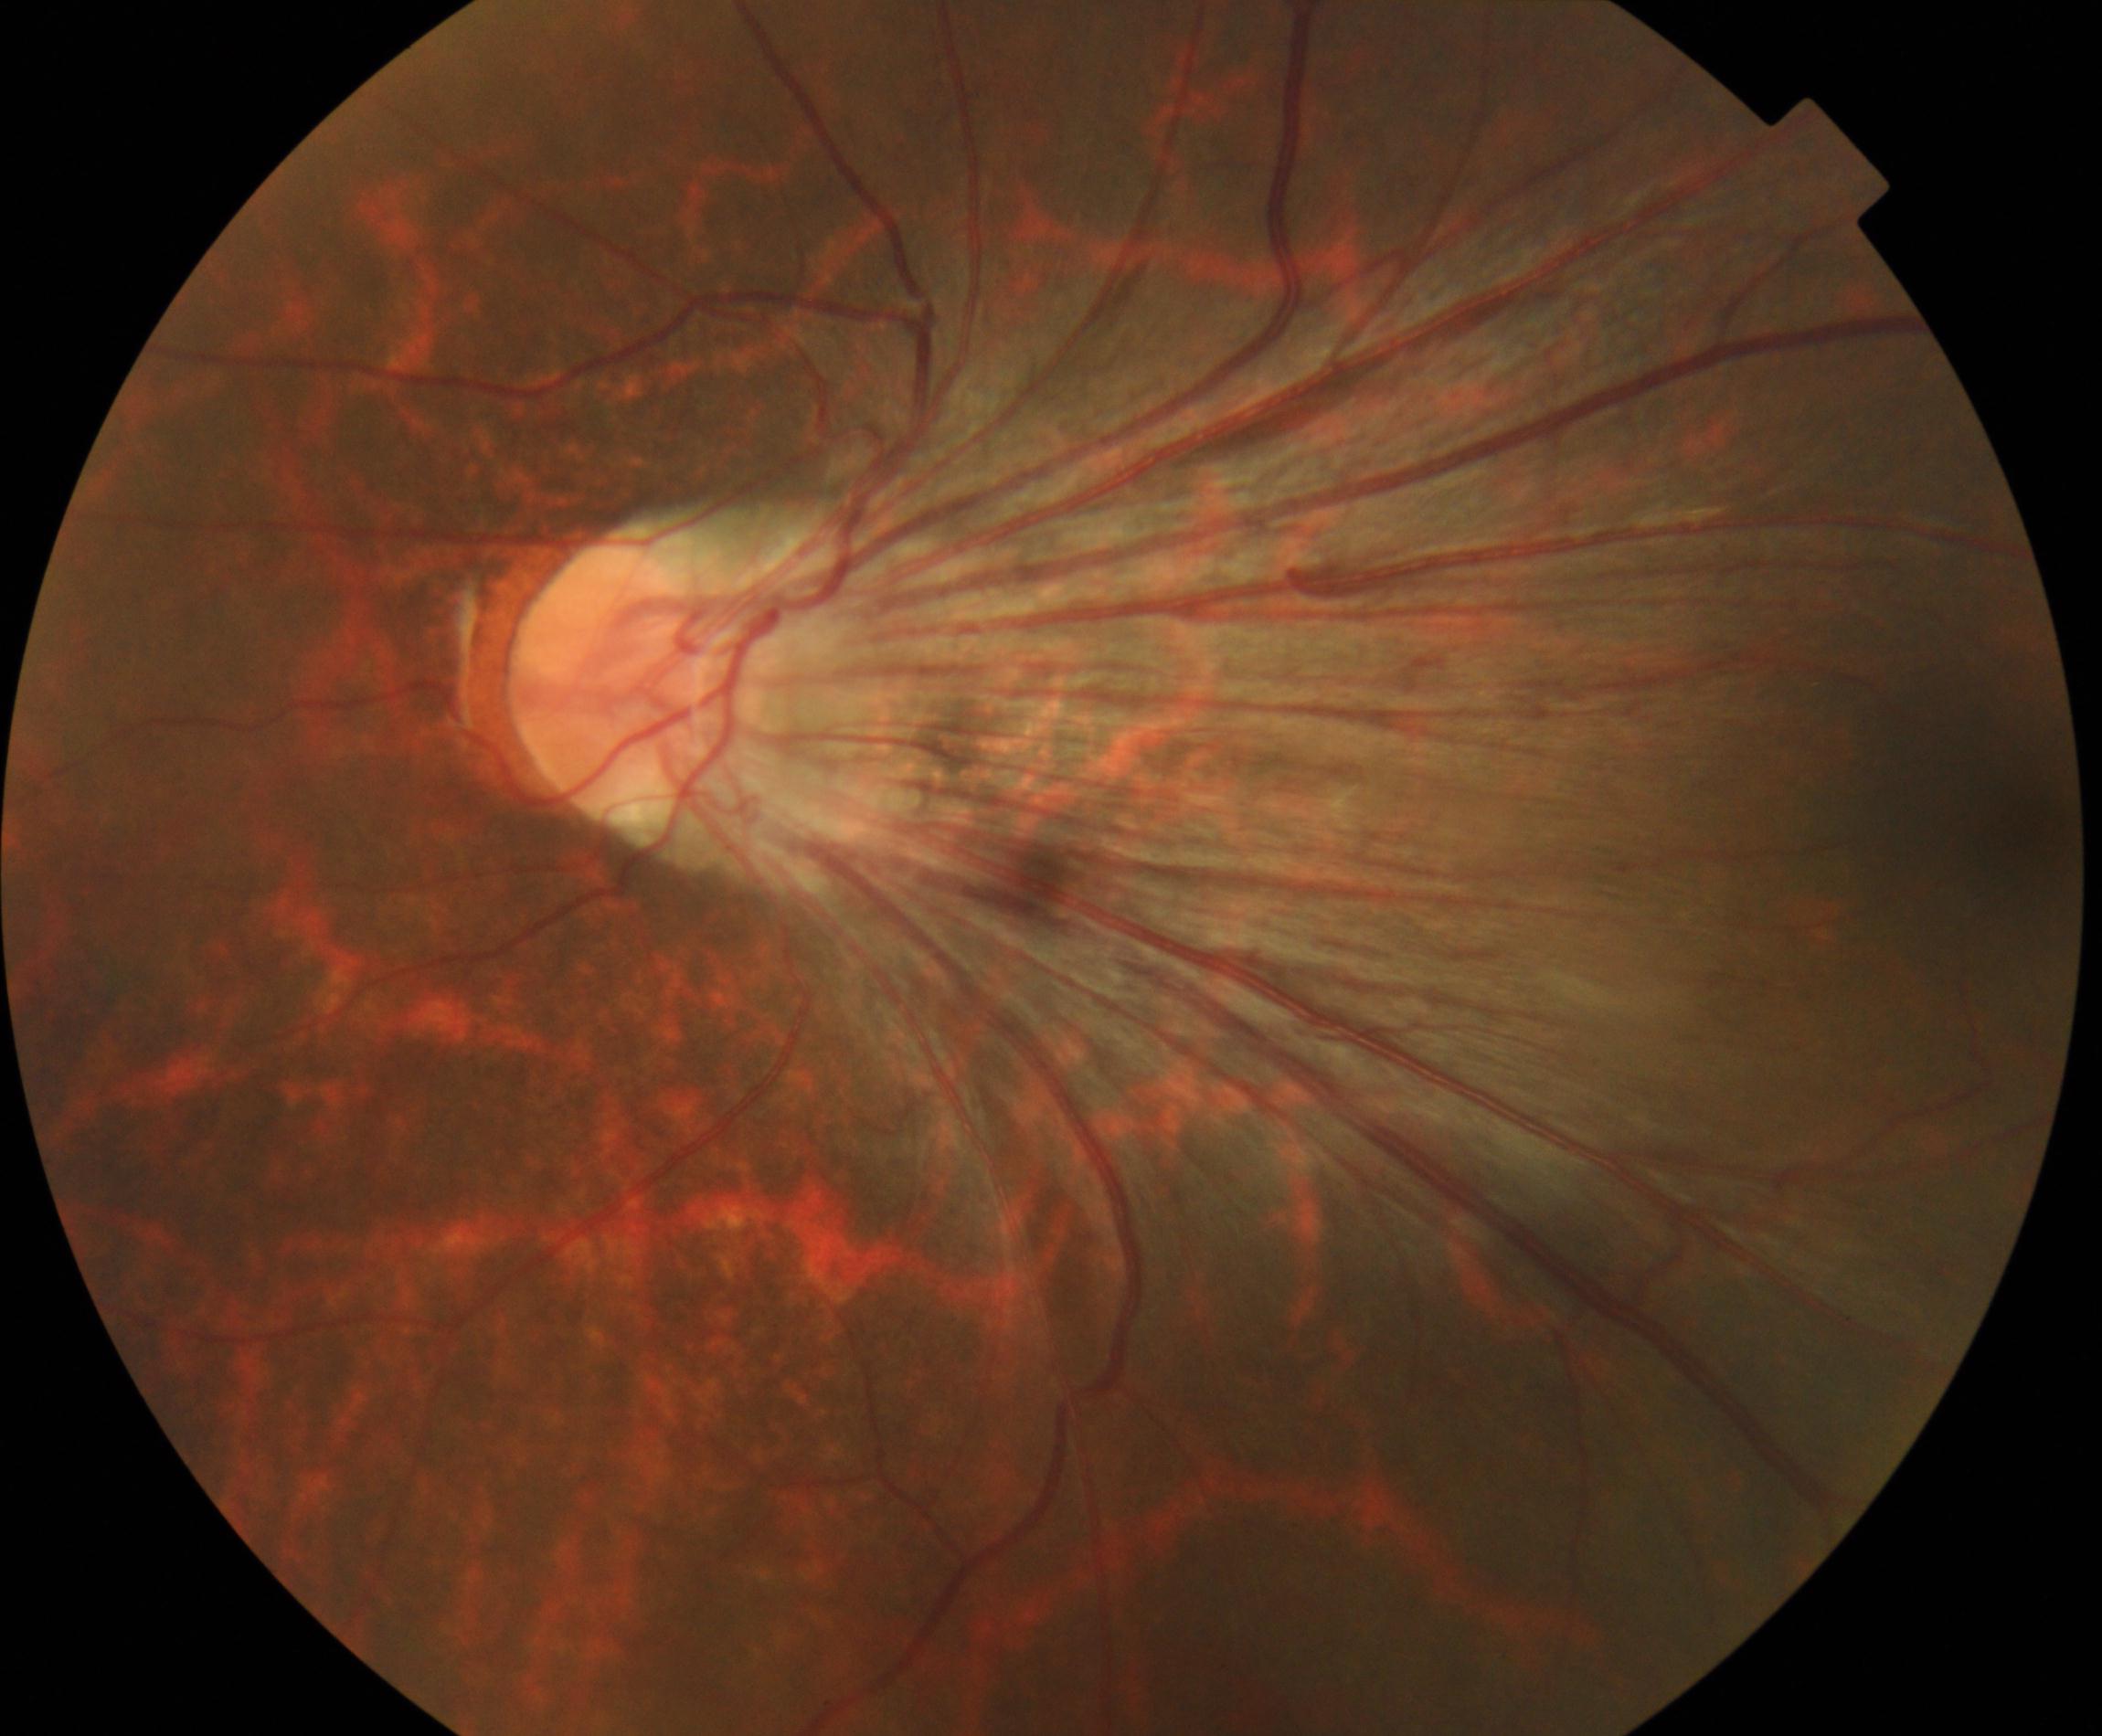 This fundus photograph shows dragged disc.